Image size 1659x2212, color fundus photograph — 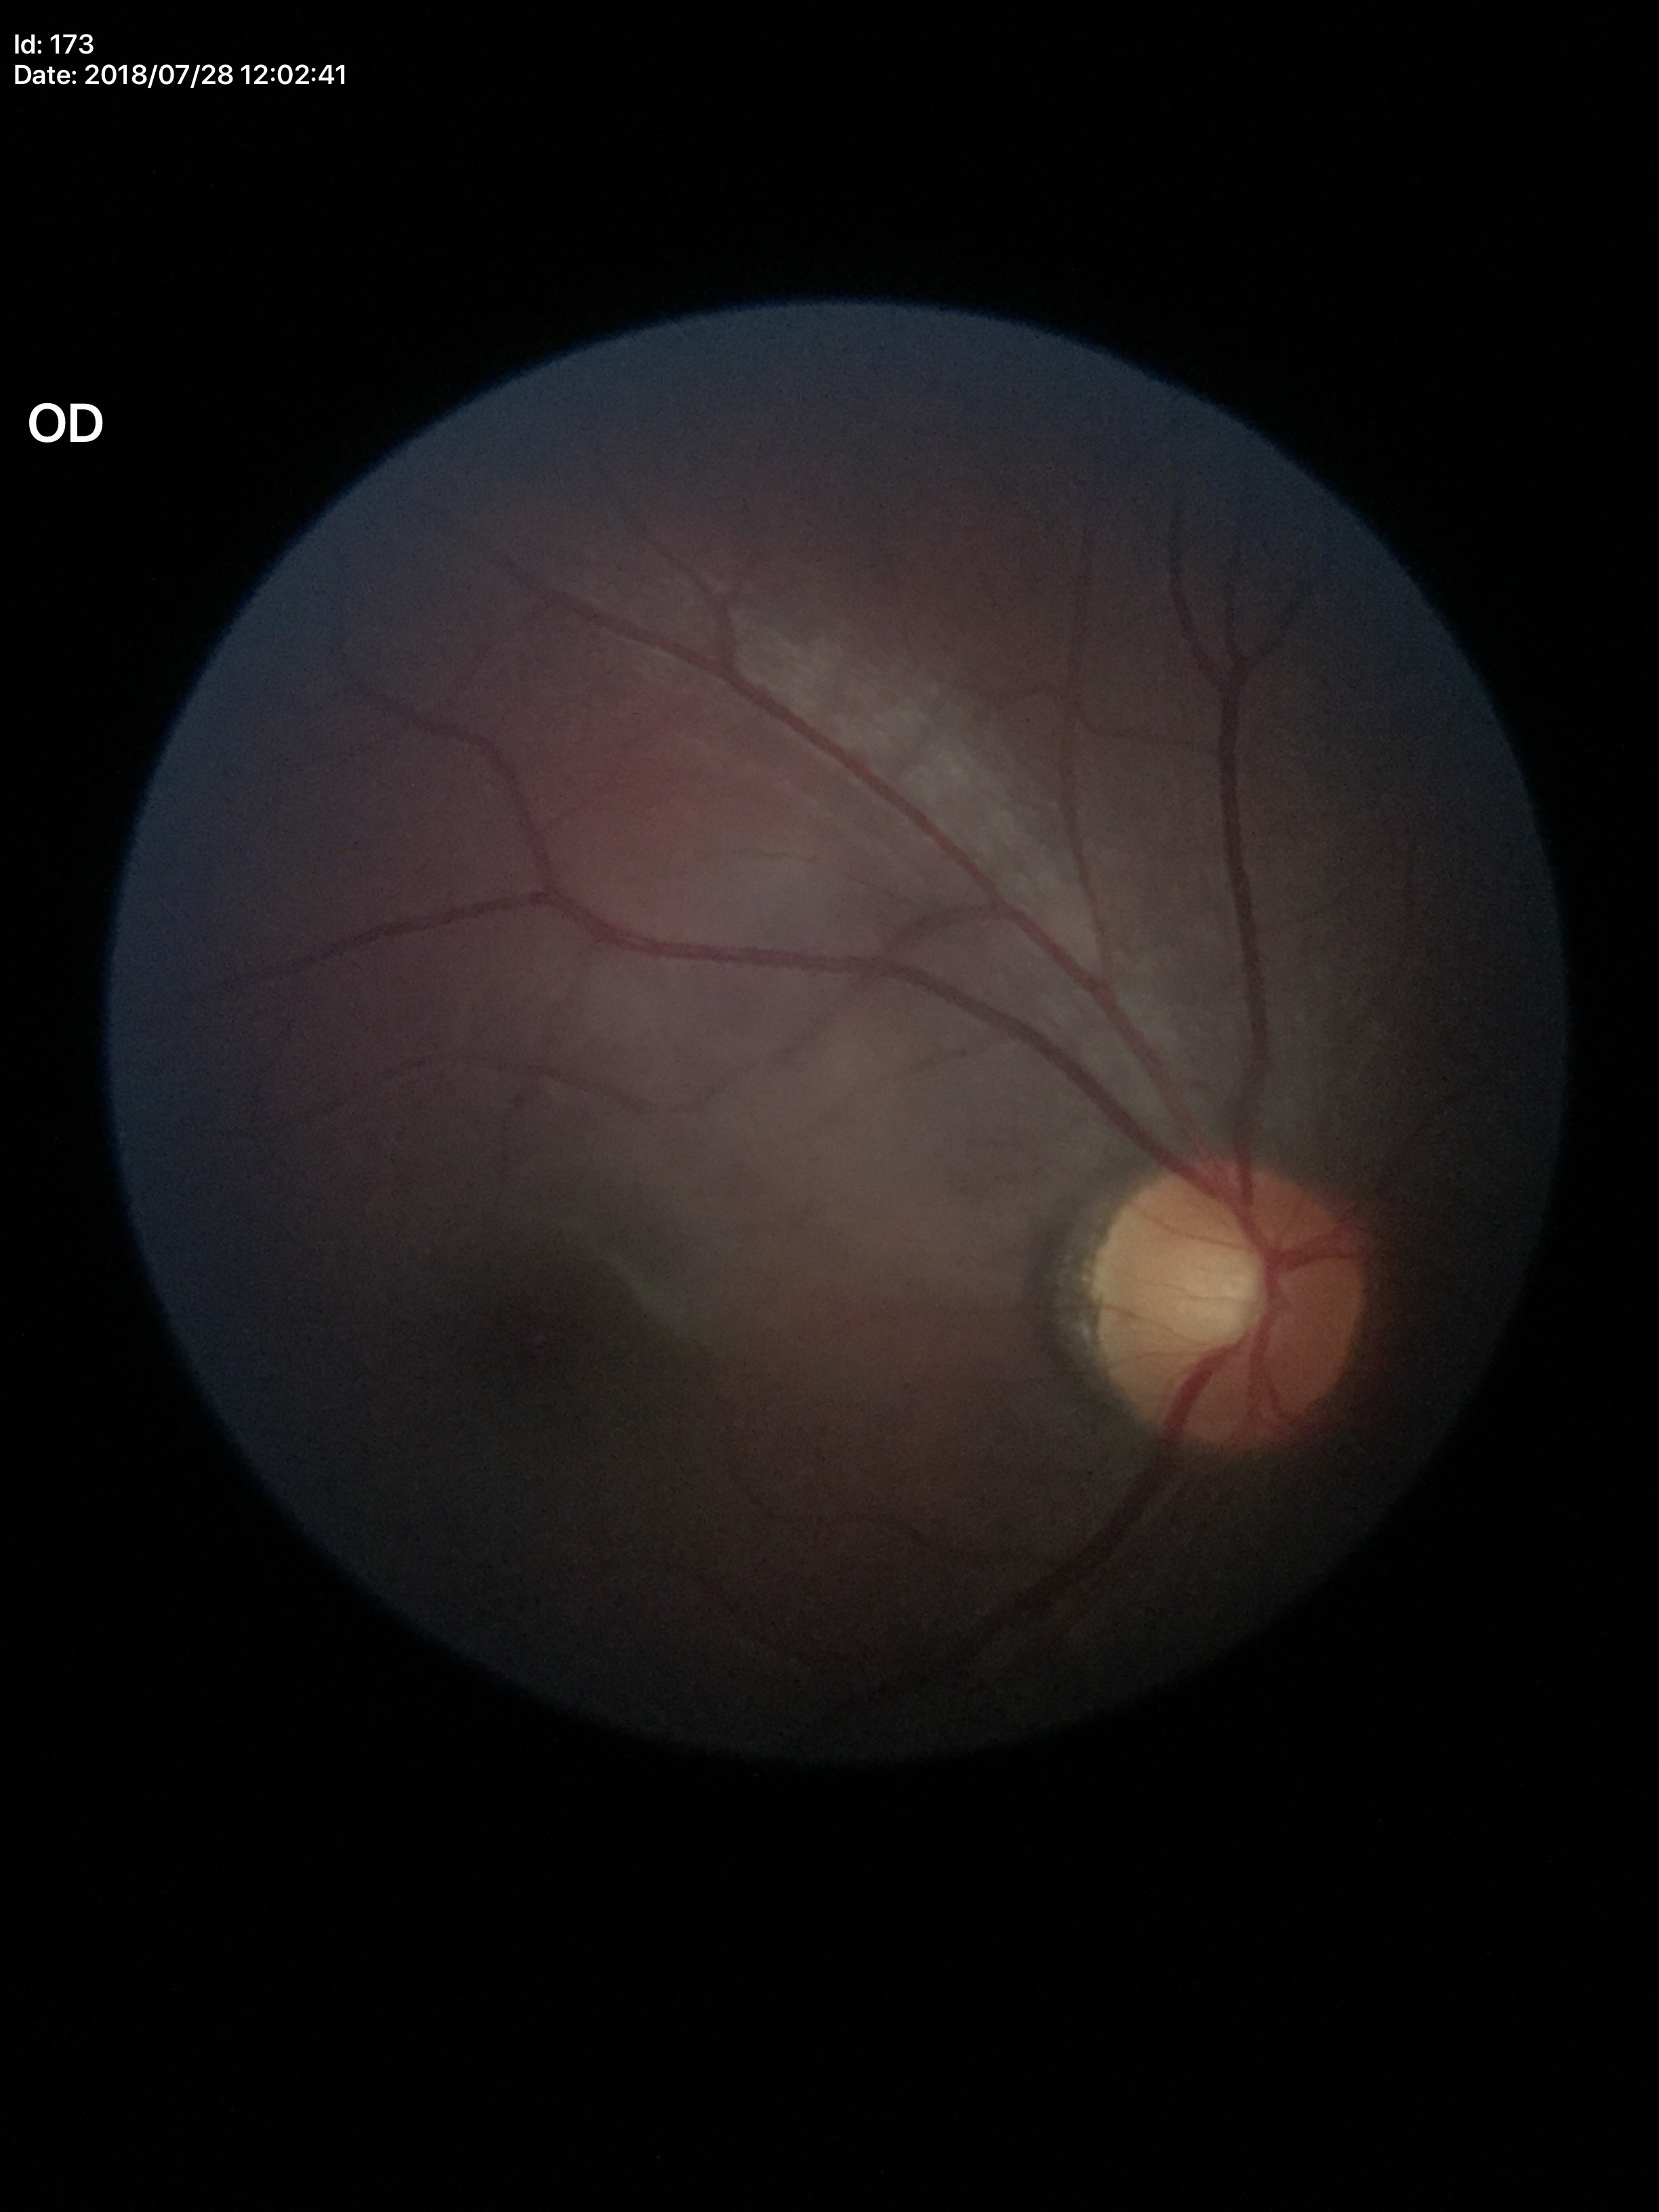 {"glaucoma_decision": "not suspect", "vcdr": "0.52", "acdr": "0.27", "hcdr": "0.52"}